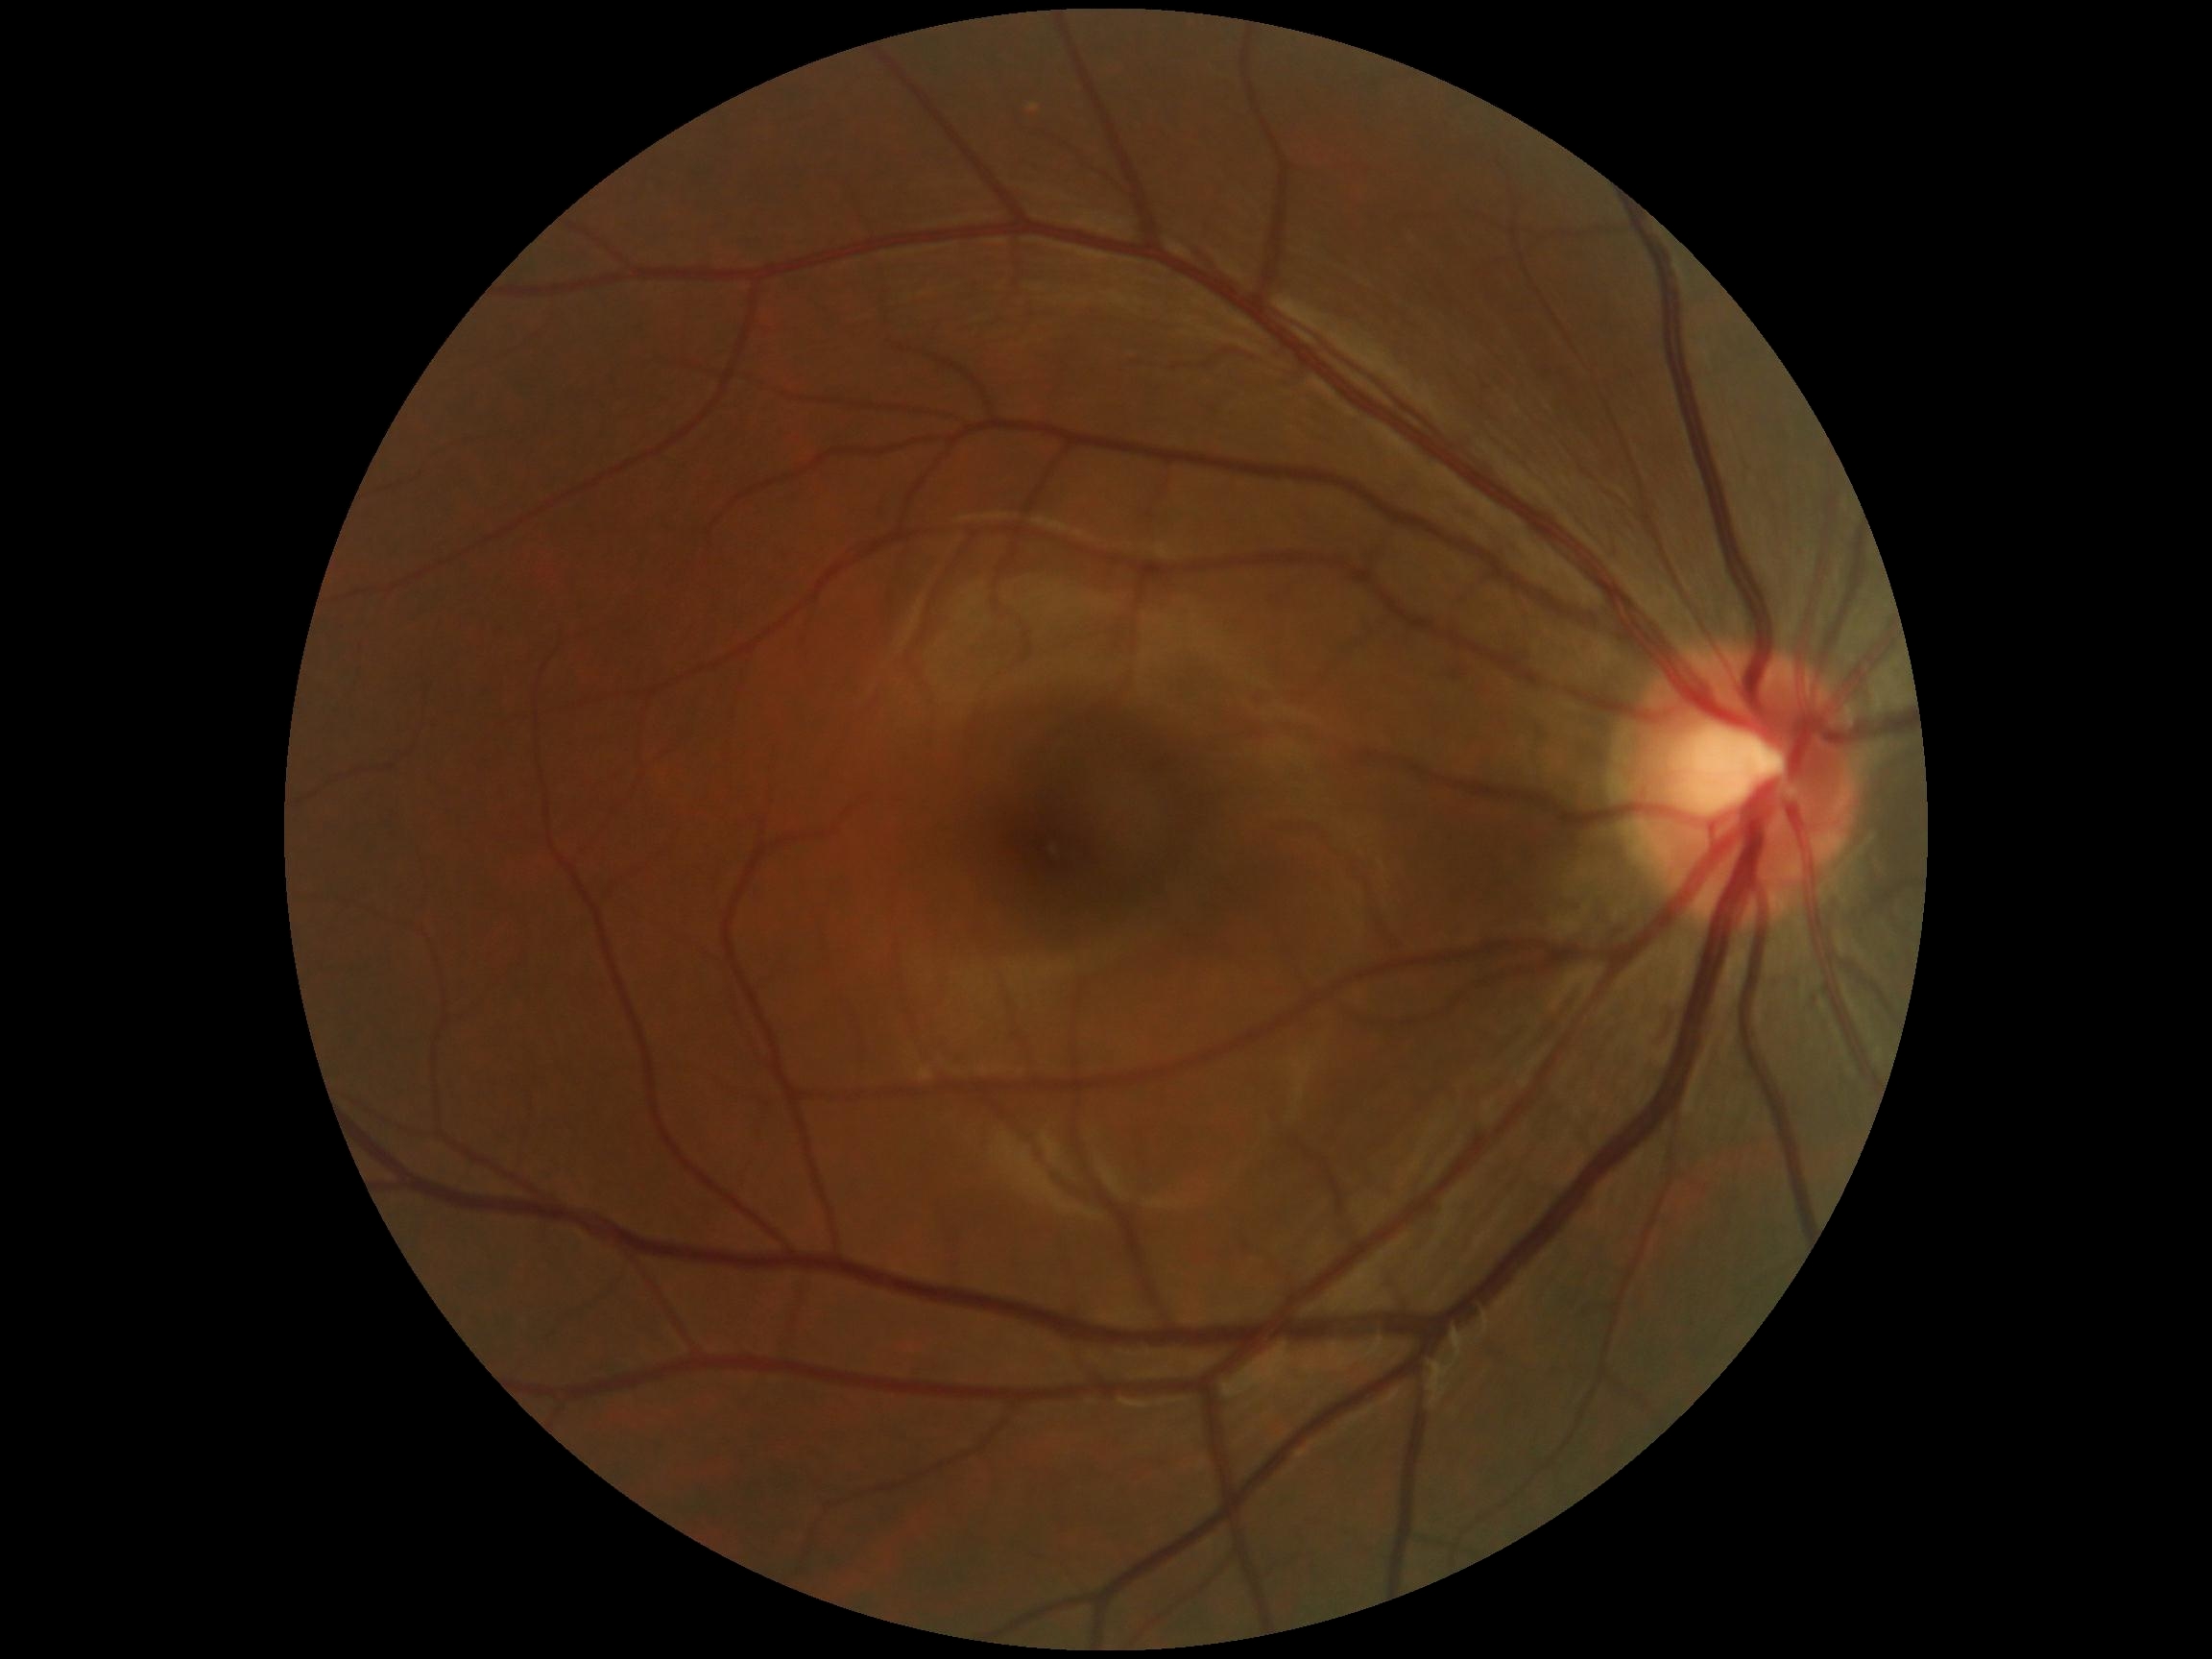

  dr_grade: no apparent diabetic retinopathy (0) — no visible signs of diabetic retinopathy